45° field of view. Image size 2184x1690
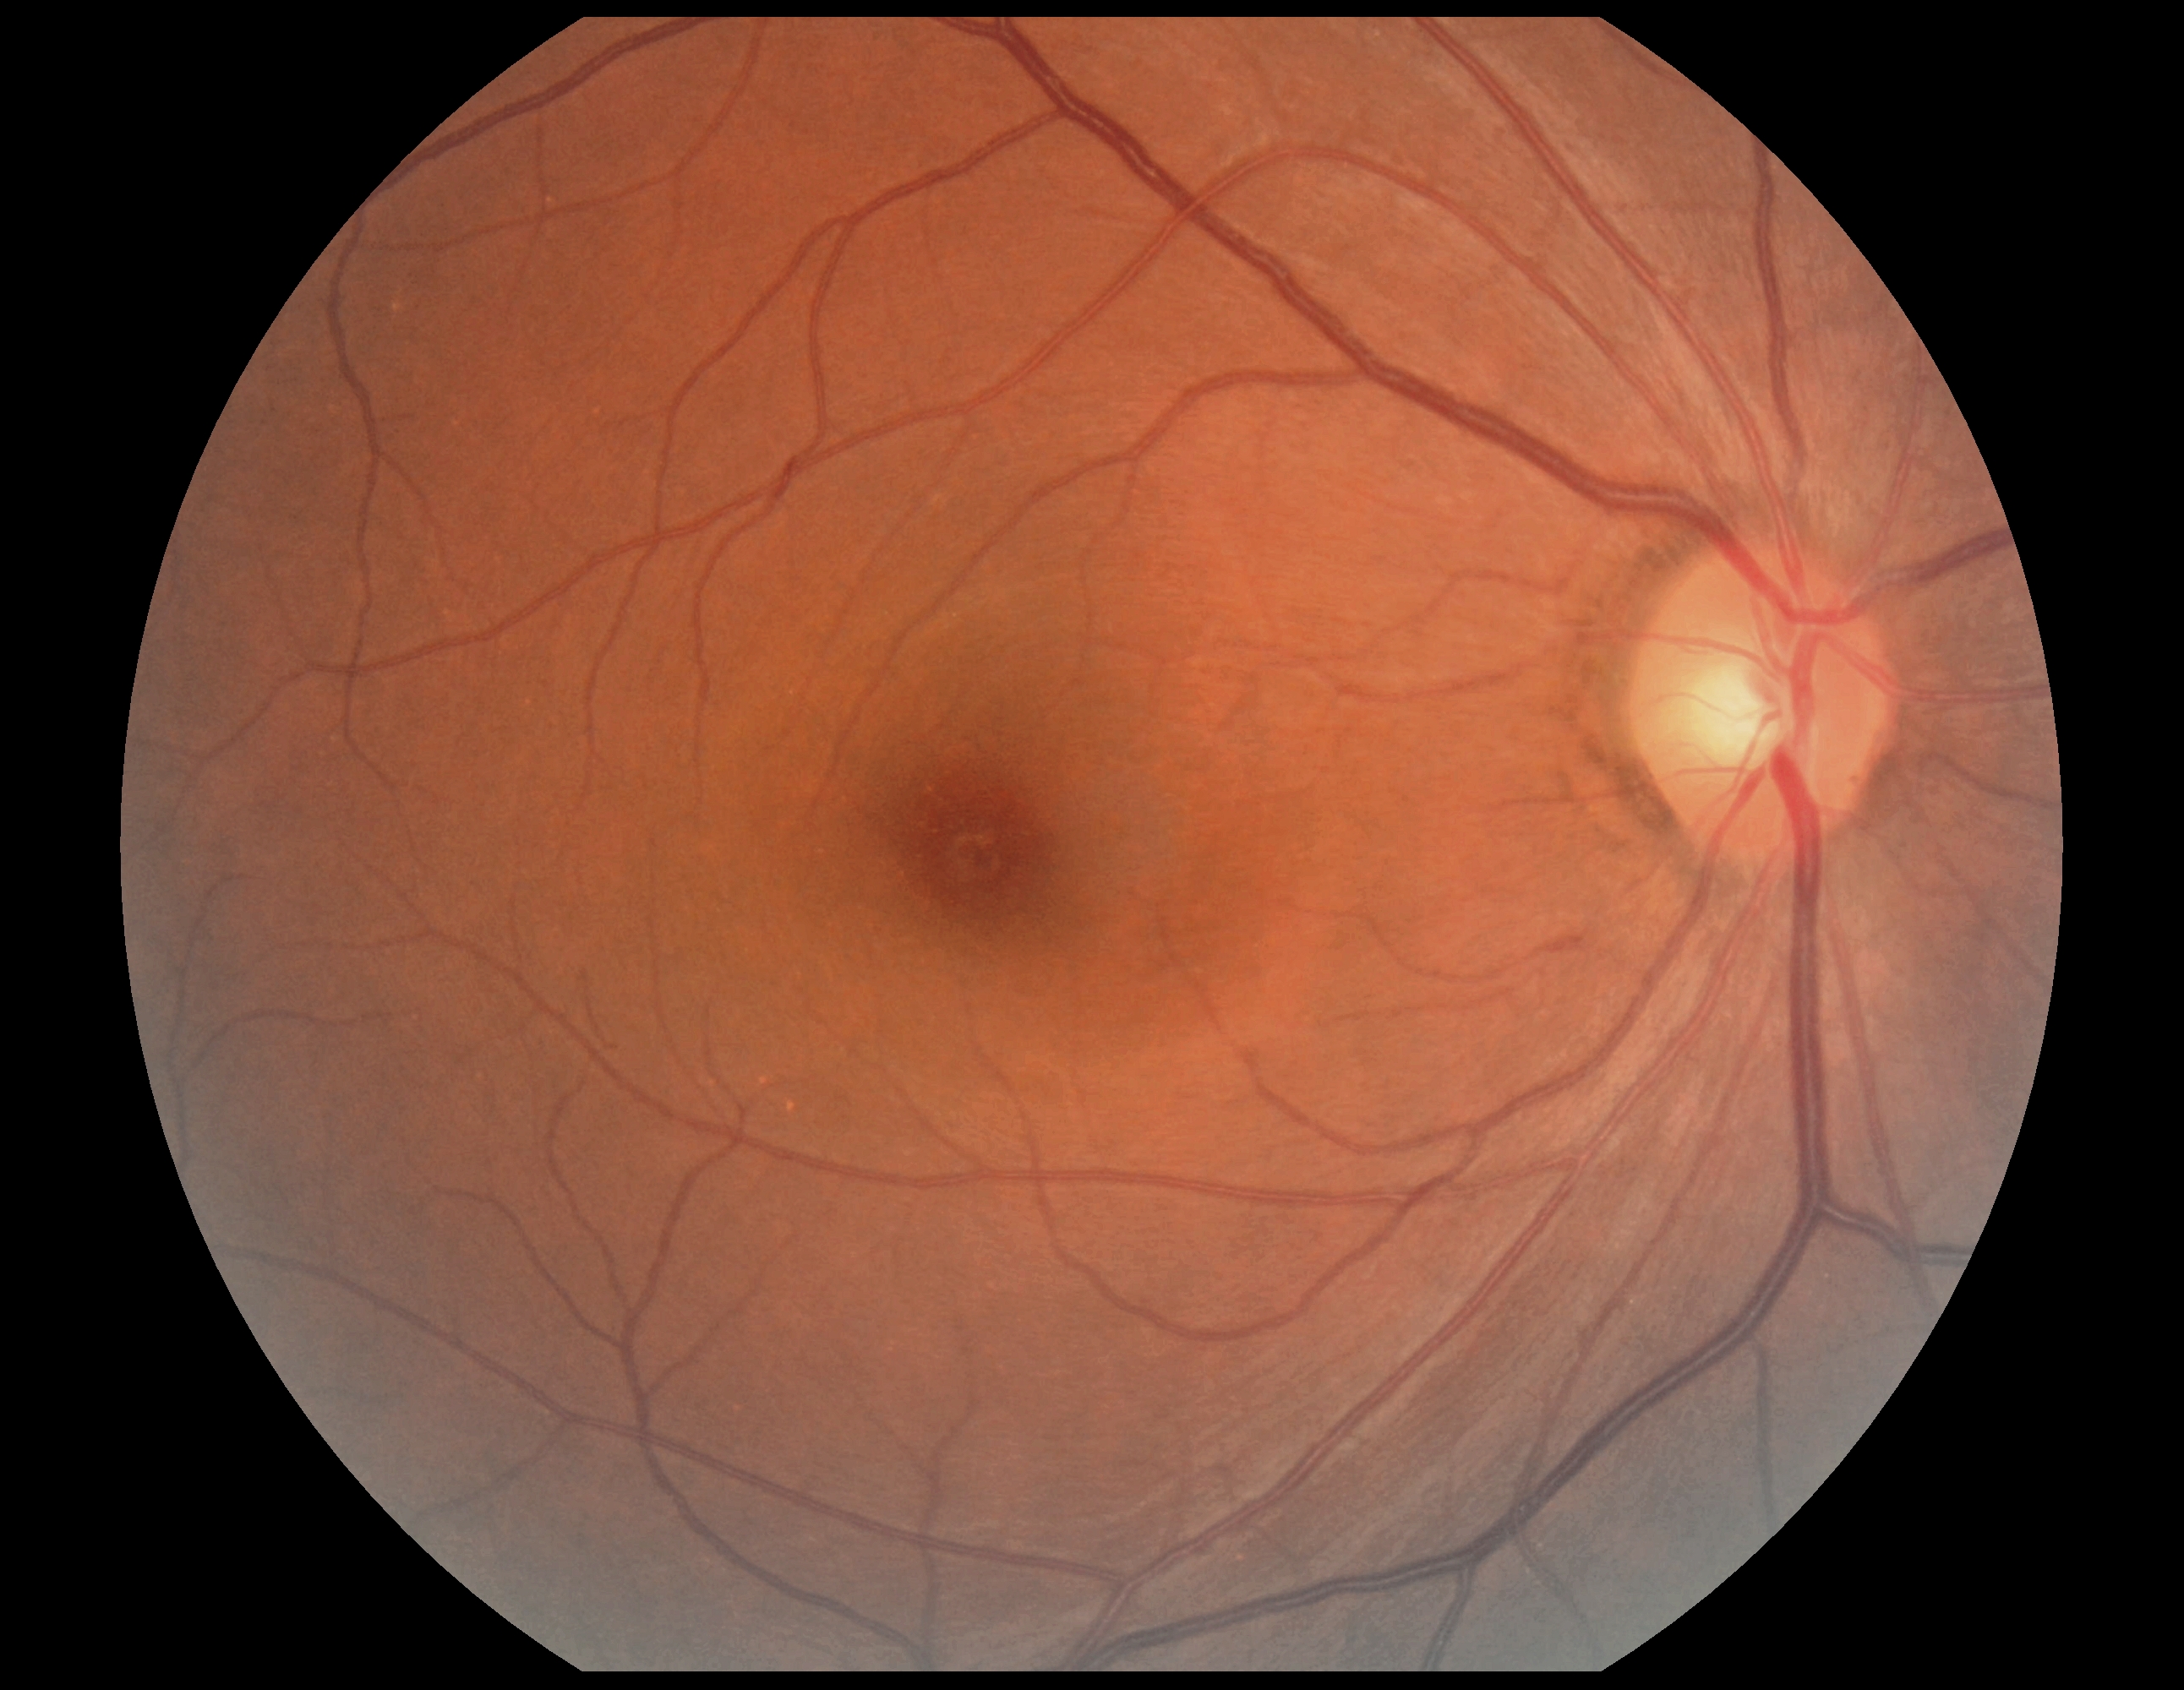

DR impression@no DR findings, DR stage@no apparent retinopathy (grade 0).